Acquired on the Phoenix ICON. Infant wide-field retinal image. 1240x1240px — 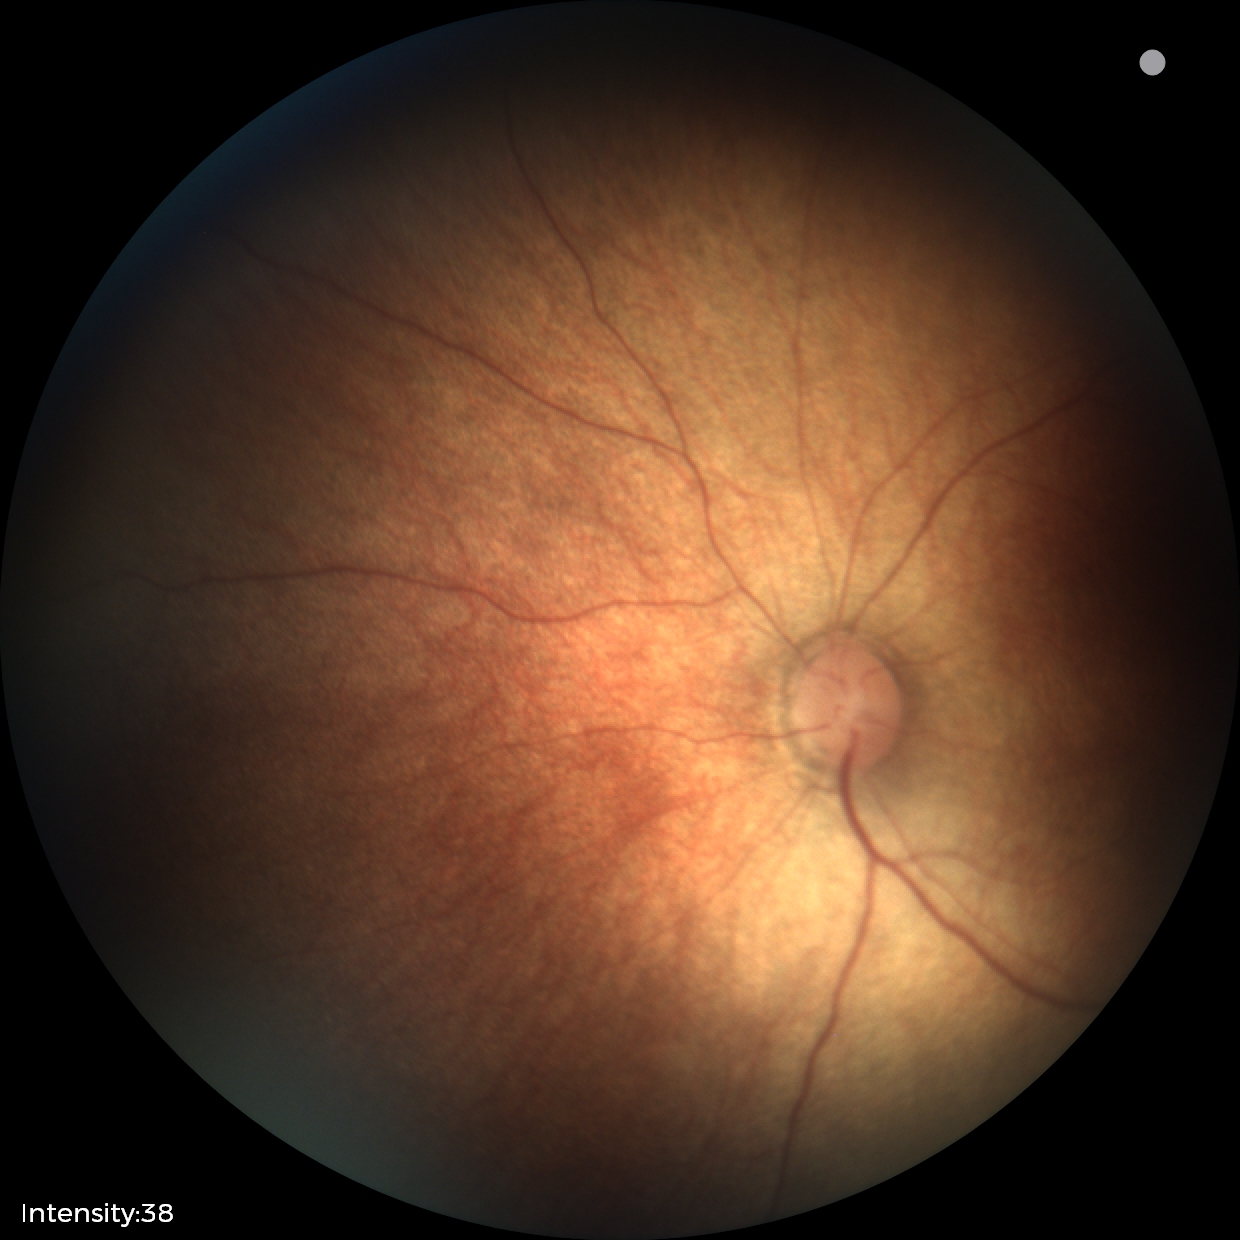
Q: What is the screening diagnosis?
A: normal retinal appearance